Wide-field fundus image from infant ROP screening — 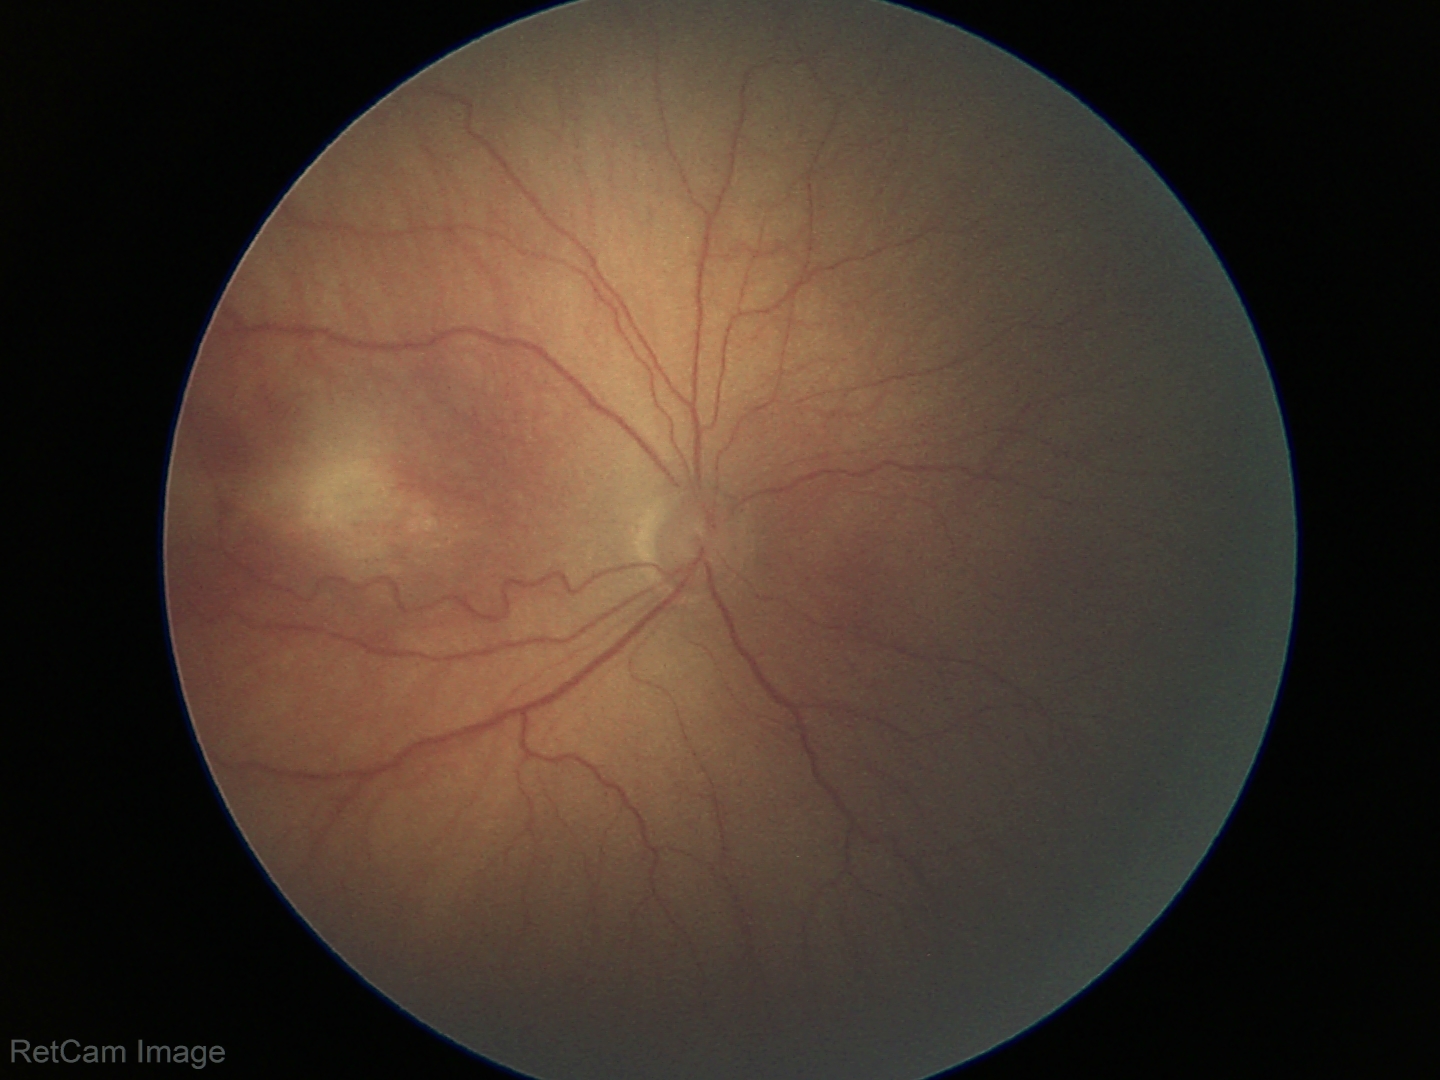 Plus disease absent. Diagnosis from this screening exam: retinopathy of prematurity stage 3.